Without pupil dilation, 848 x 848 pixels, 45 degree fundus photograph
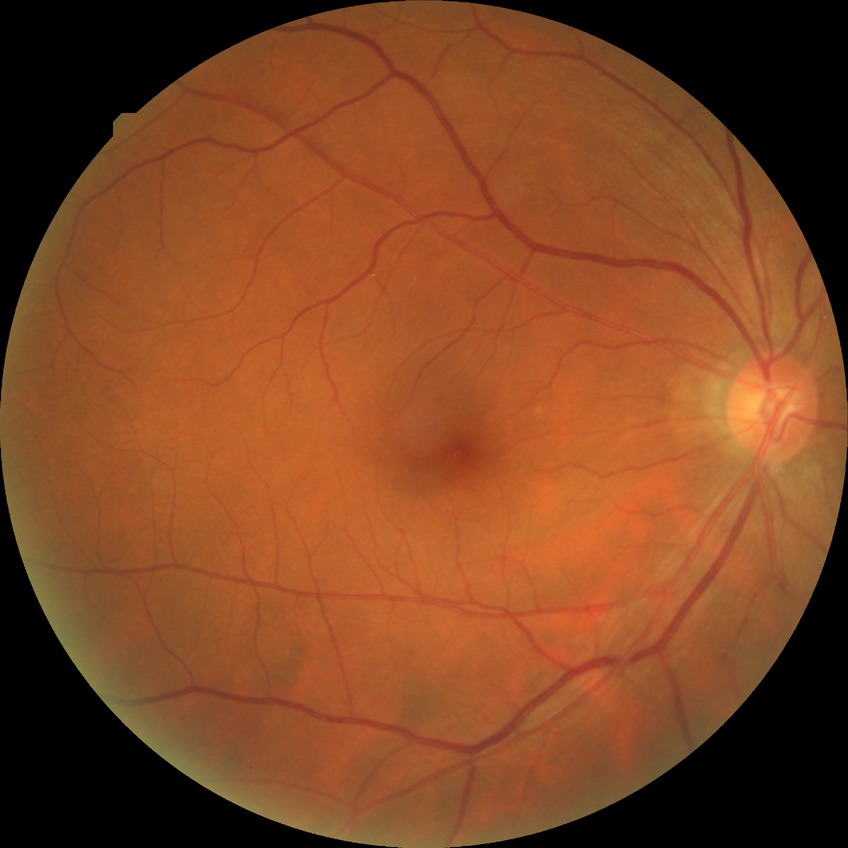

  davis_grade: simple diabetic retinopathy (SDR)